Phoenix ICON wide-field infant fundus image:
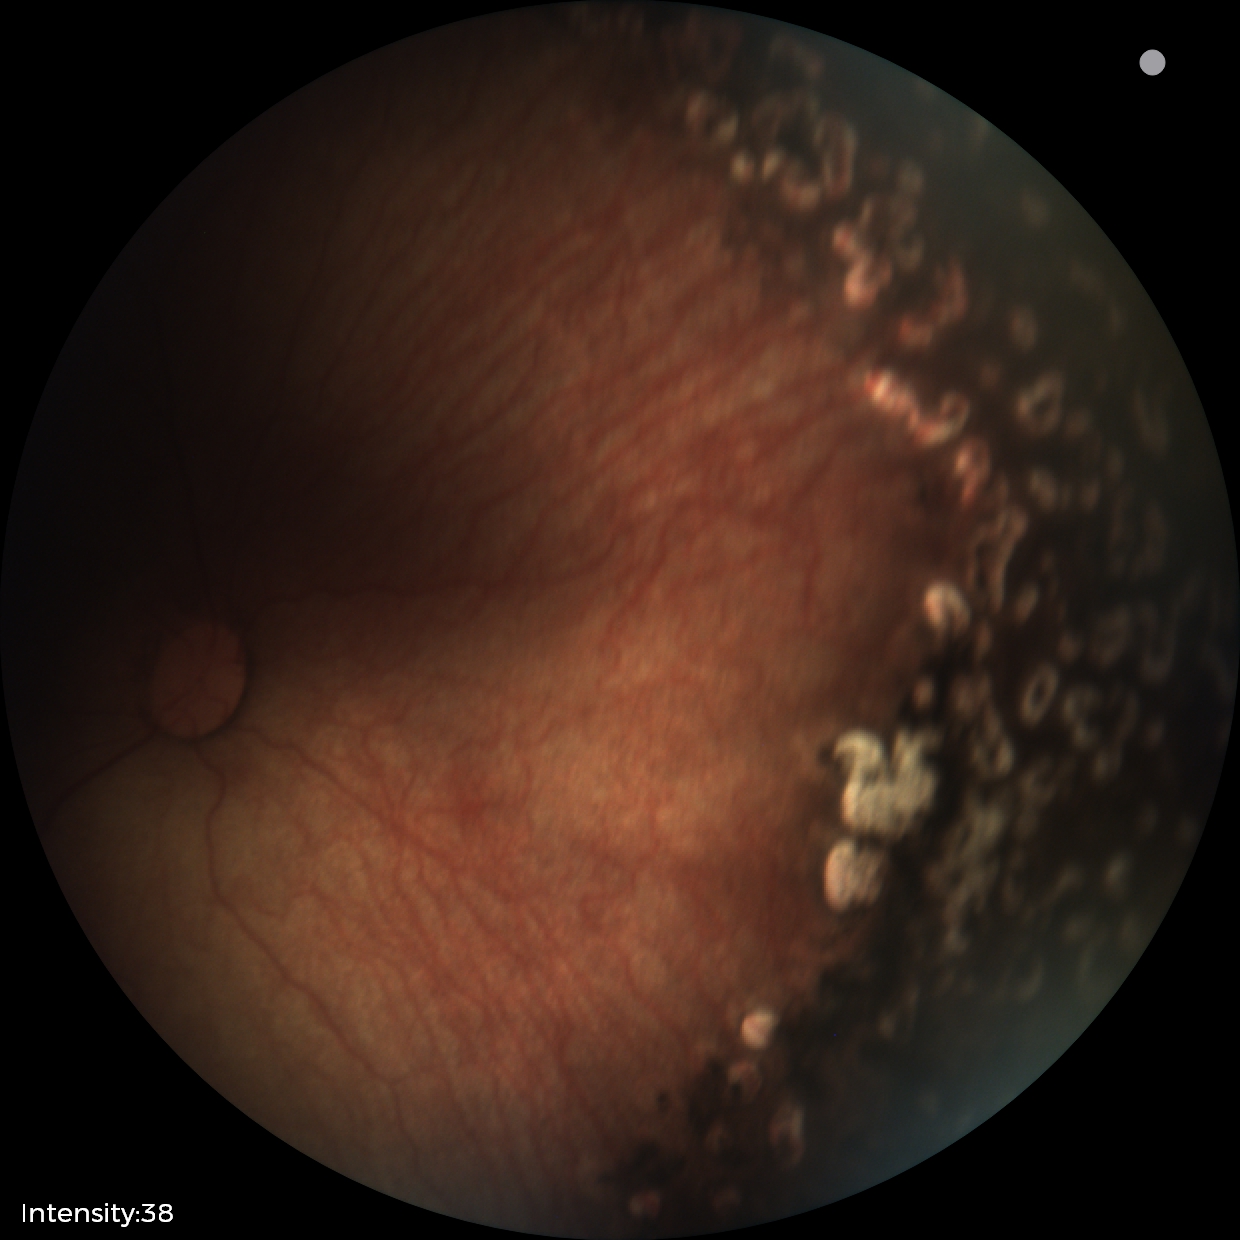

Diagnosis from this screening exam: status post ROP.